Color fundus photograph
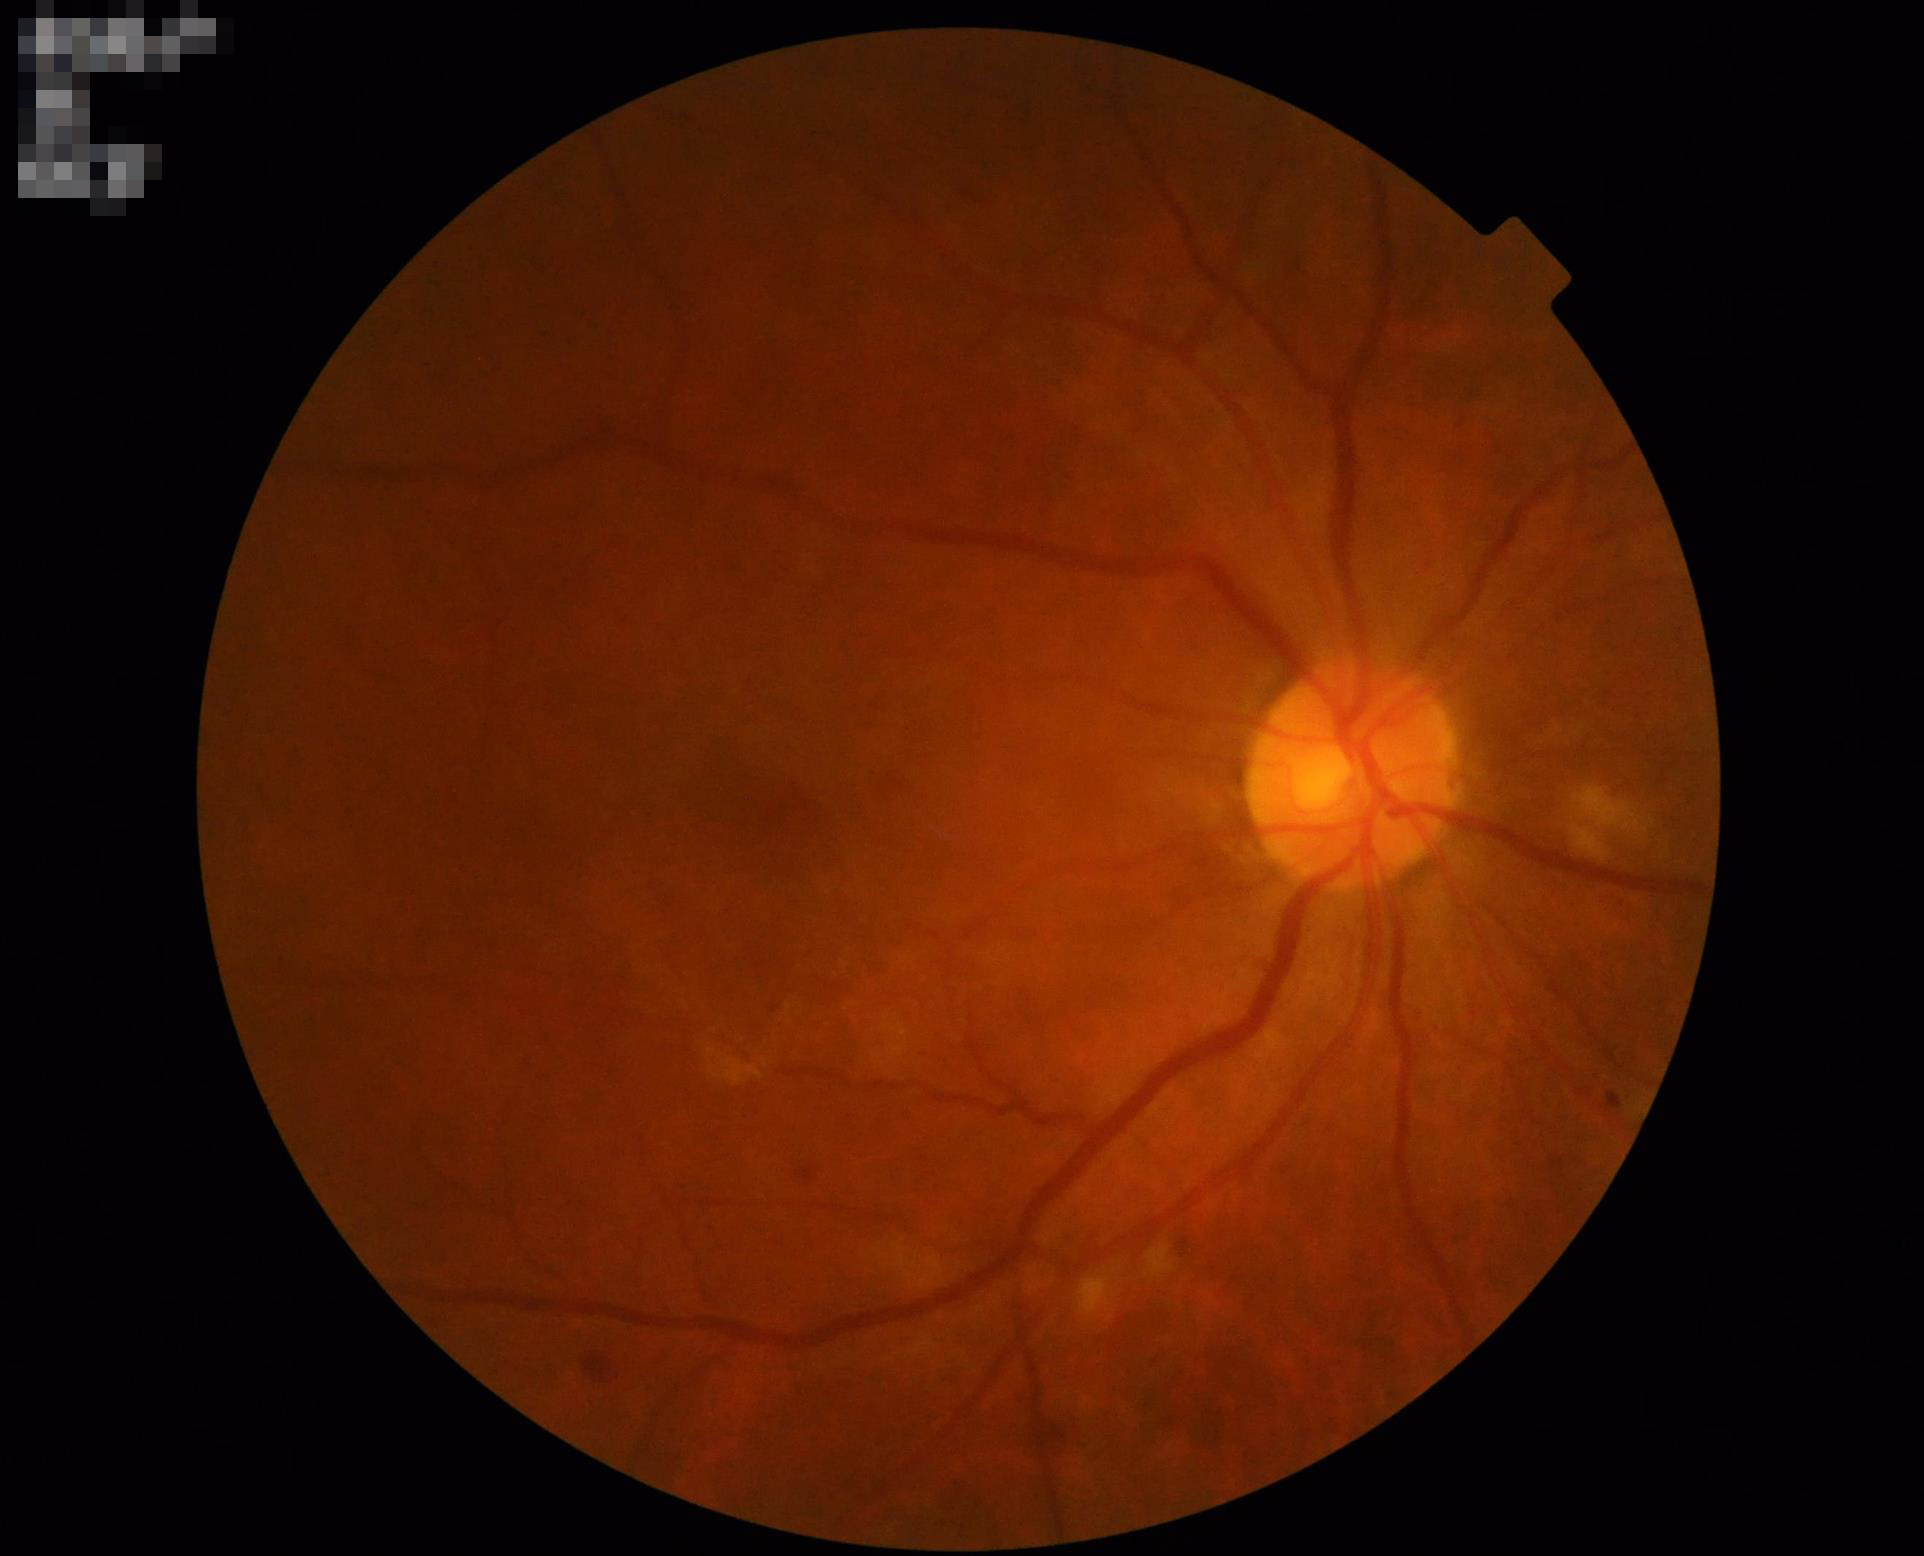

The image is clear.
No over- or under-exposure.
Overall image quality is good.